640 x 480 pixels; wide-field fundus photograph from neonatal ROP screening:
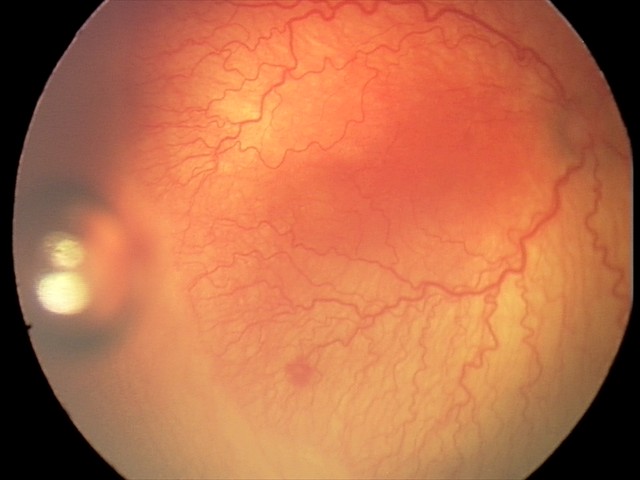 With plus disease. From an examination with diagnosis of aggressive retinopathy of prematurity — rapidly progressive severe ROP with prominent plus disease, often without classic stage progression.